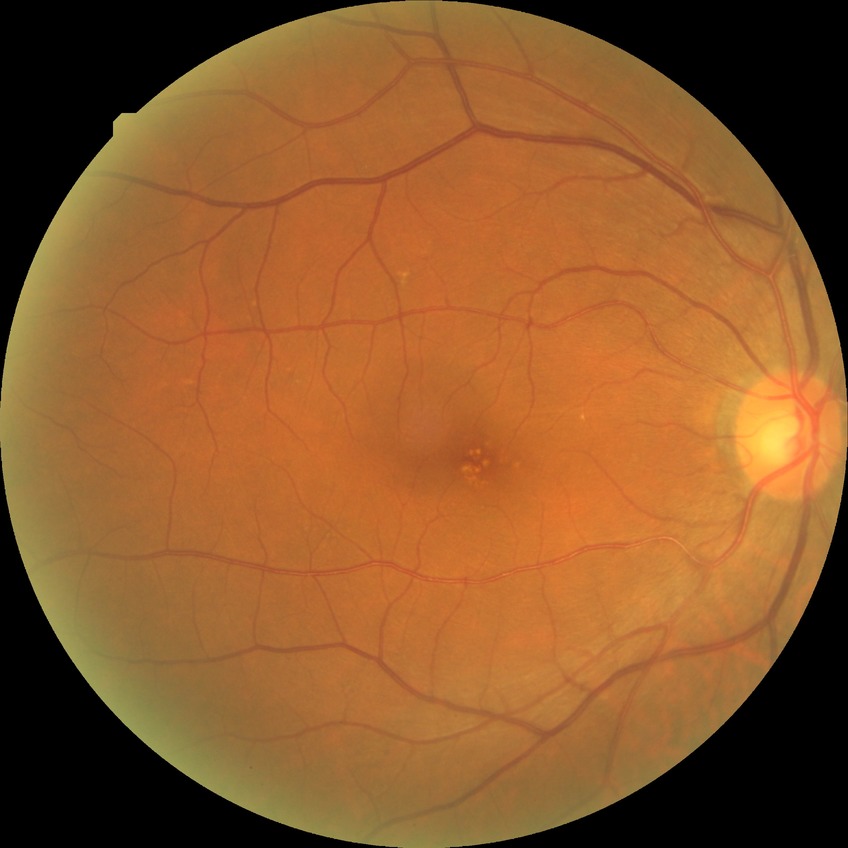 {"davis_grade": "no diabetic retinopathy"}